Diabetic retinopathy graded by the modified Davis classification:
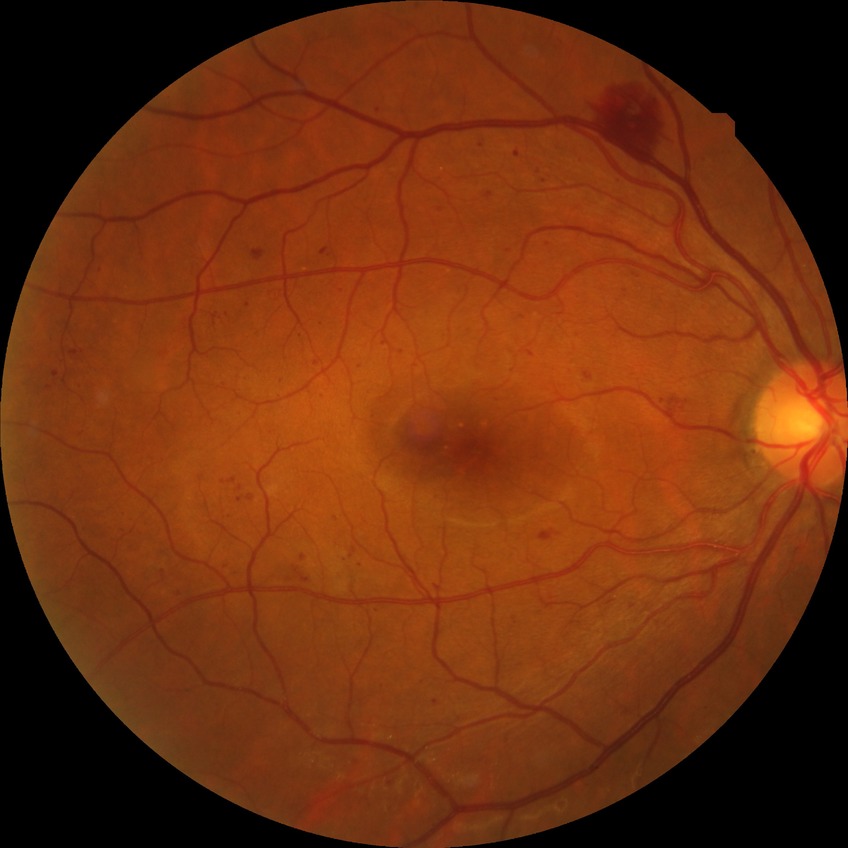

Diabetic retinopathy (DR) is PPDR (pre-proliferative diabetic retinopathy).